Wide-field fundus photograph of an infant.
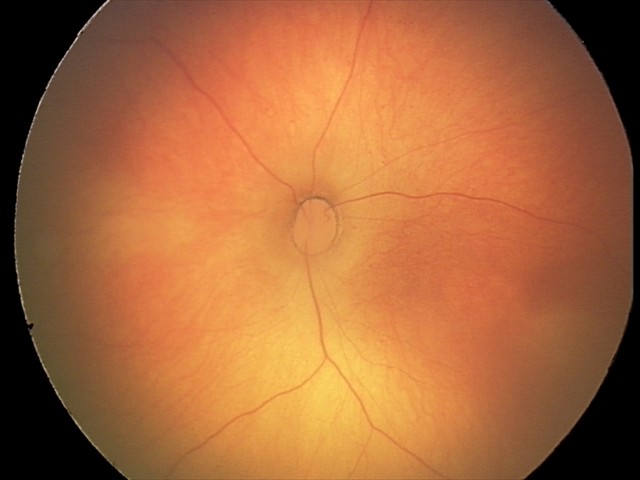 Finding: no abnormalities